45-degree field of view:
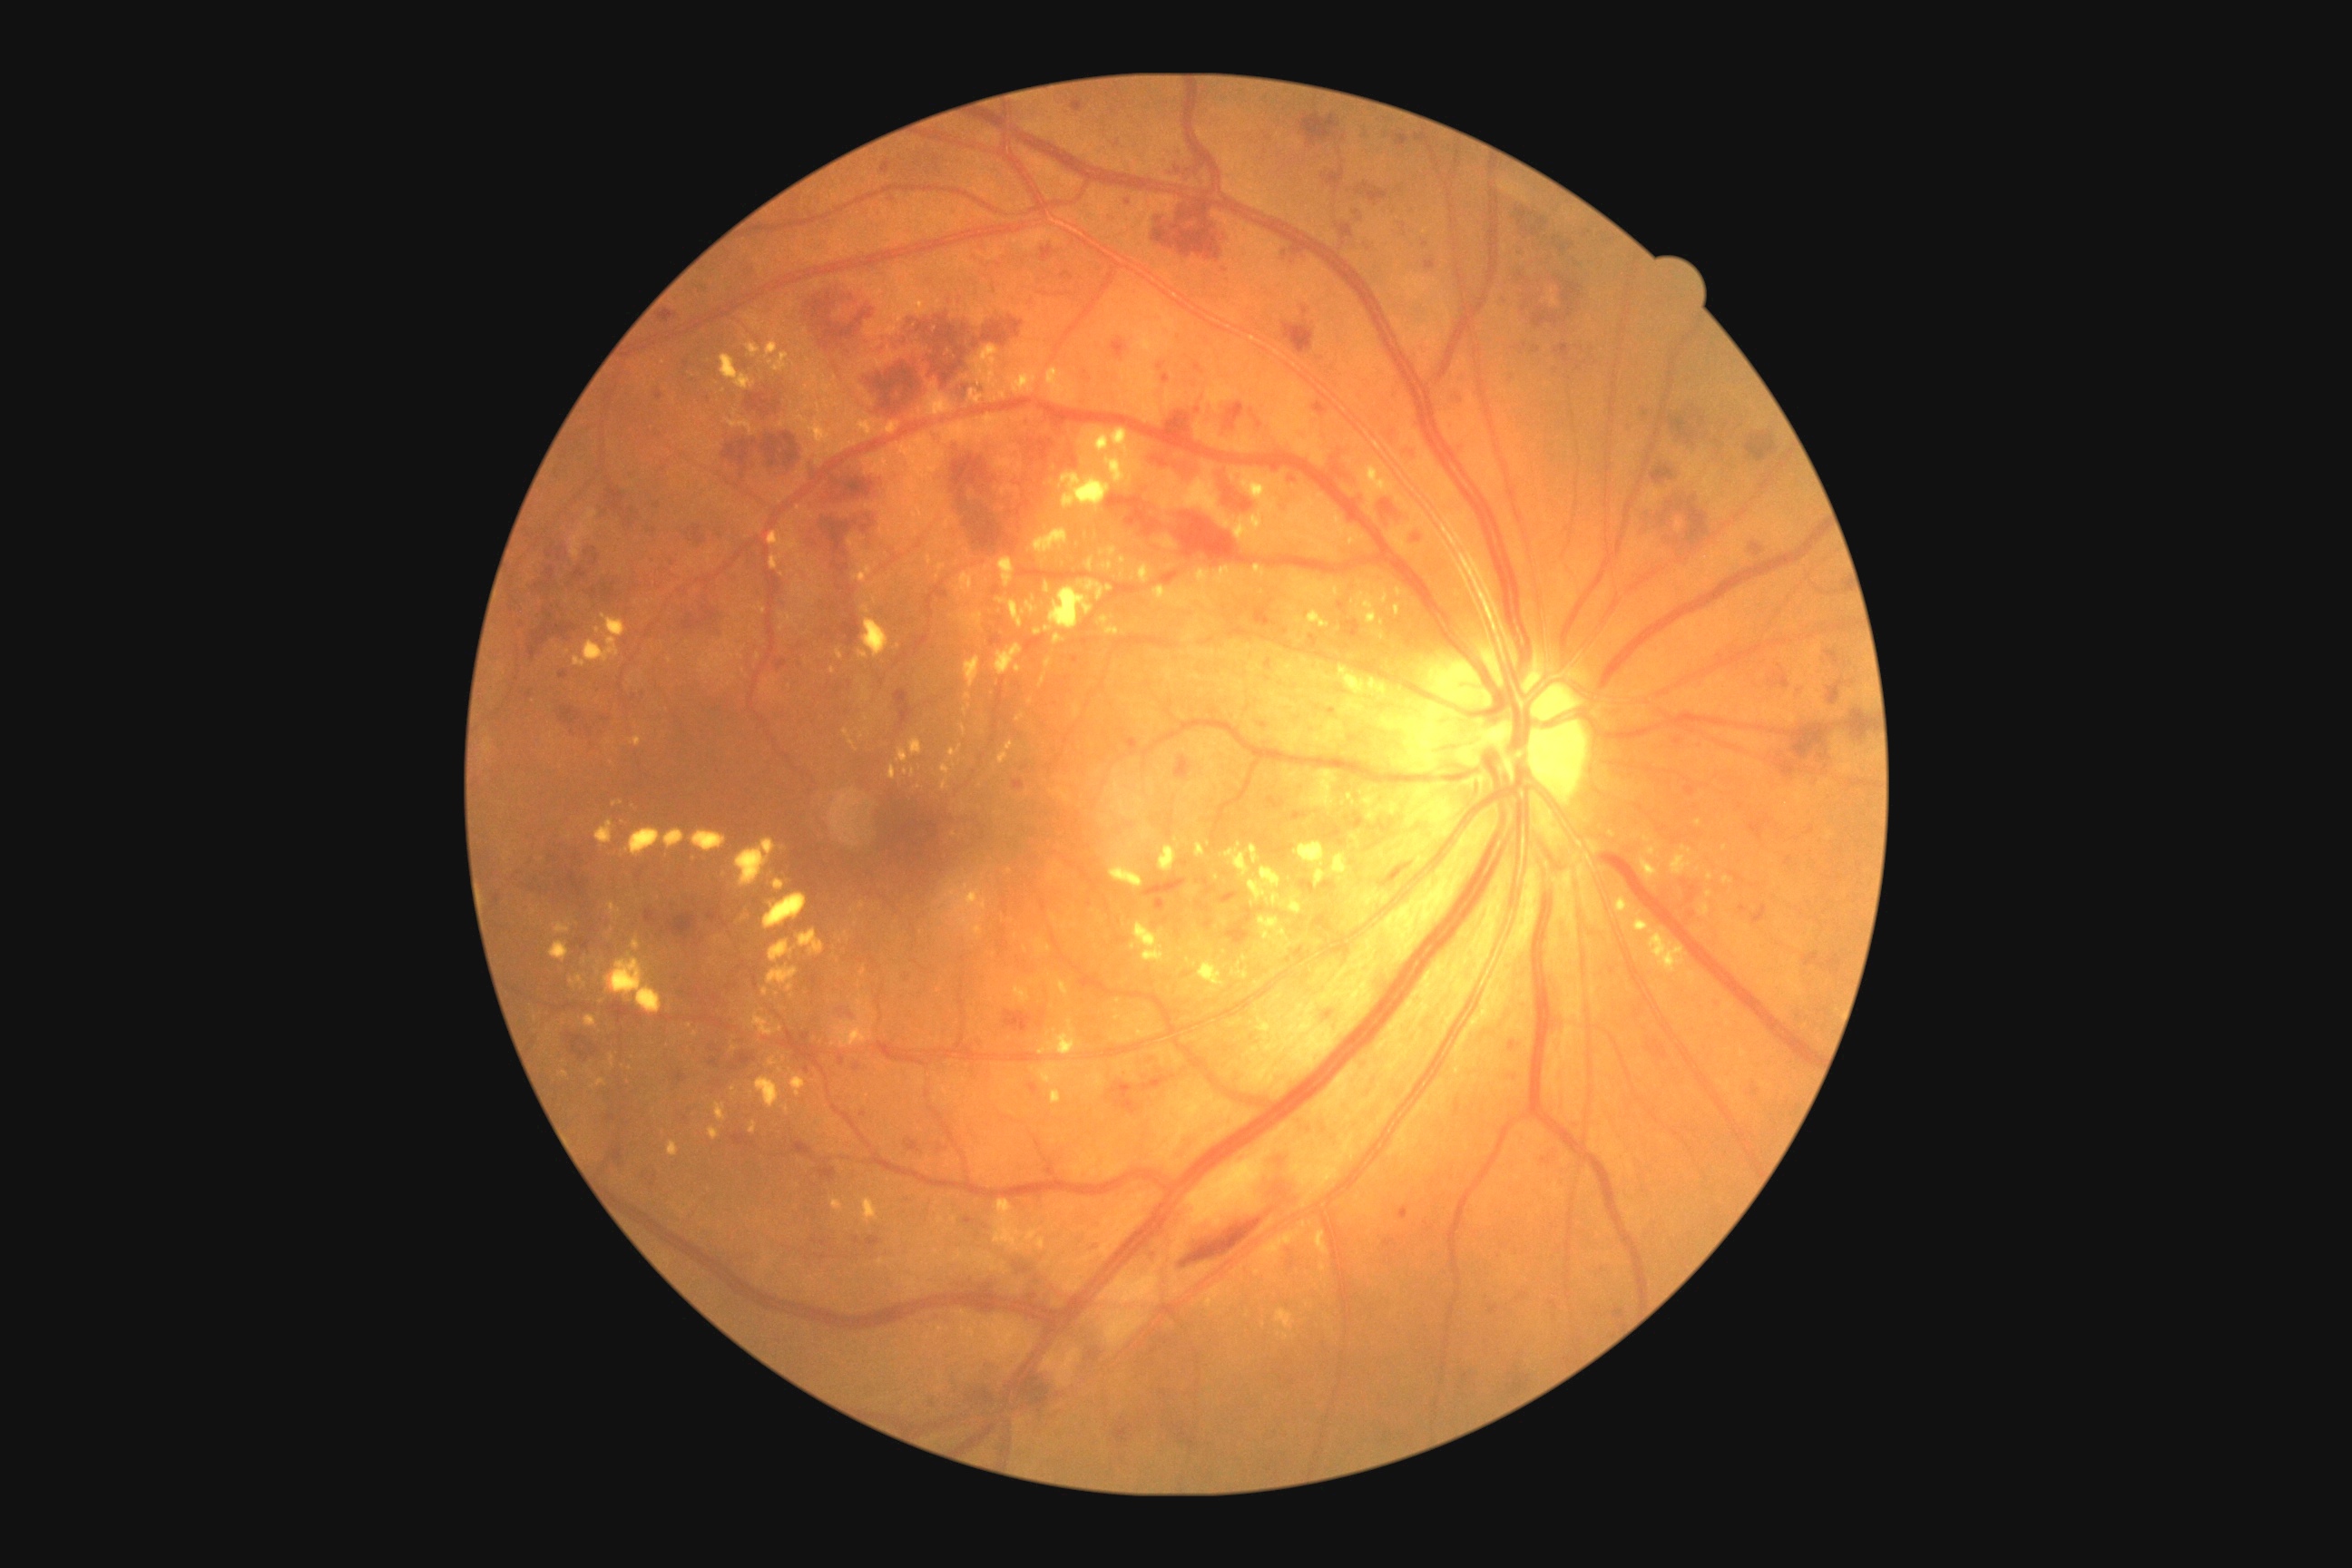 partial: true
dr_grade: 3
lesions:
  ma:
    - {"x1": 990, "y1": 634, "x2": 1003, "y2": 647}
    - {"x1": 1426, "y1": 260, "x2": 1436, "y2": 270}
    - {"x1": 1807, "y1": 827, "x2": 1816, "y2": 836}
    - {"x1": 654, "y1": 391, "x2": 663, "y2": 400}
    - {"x1": 805, "y1": 1066, "x2": 810, "y2": 1075}
    - {"x1": 1313, "y1": 402, "x2": 1329, "y2": 416}
    - {"x1": 1398, "y1": 1208, "x2": 1409, "y2": 1220}
    - {"x1": 605, "y1": 1115, "x2": 618, "y2": 1124}
    - {"x1": 937, "y1": 1142, "x2": 948, "y2": 1153}
    - {"x1": 1219, "y1": 892, "x2": 1240, "y2": 905}
    - {"x1": 1752, "y1": 1086, "x2": 1759, "y2": 1095}
    - {"x1": 1210, "y1": 709, "x2": 1219, "y2": 716}
    - {"x1": 881, "y1": 161, "x2": 892, "y2": 173}
    - {"x1": 1019, "y1": 1268, "x2": 1032, "y2": 1273}
    - {"x1": 1164, "y1": 917, "x2": 1170, "y2": 925}
    - {"x1": 1197, "y1": 879, "x2": 1217, "y2": 896}
    - {"x1": 605, "y1": 1144, "x2": 625, "y2": 1164}
  ma_small_centers:
    - {"x": 1185, "y": 864}
    - {"x": 657, "y": 506}
  he:
    - {"x1": 1181, "y1": 1208, "x2": 1277, "y2": 1268}
    - {"x1": 1337, "y1": 224, "x2": 1355, "y2": 251}
    - {"x1": 1175, "y1": 758, "x2": 1191, "y2": 779}
    - {"x1": 558, "y1": 671, "x2": 569, "y2": 680}
    - {"x1": 618, "y1": 1148, "x2": 625, "y2": 1164}
    - {"x1": 602, "y1": 583, "x2": 618, "y2": 602}
    - {"x1": 591, "y1": 589, "x2": 598, "y2": 600}
    - {"x1": 687, "y1": 525, "x2": 707, "y2": 545}
    - {"x1": 527, "y1": 609, "x2": 578, "y2": 663}
    - {"x1": 816, "y1": 1159, "x2": 838, "y2": 1184}
    - {"x1": 1393, "y1": 133, "x2": 1409, "y2": 148}
    - {"x1": 1106, "y1": 495, "x2": 1162, "y2": 538}
    - {"x1": 536, "y1": 538, "x2": 542, "y2": 547}
    - {"x1": 1280, "y1": 308, "x2": 1315, "y2": 355}
    - {"x1": 836, "y1": 607, "x2": 861, "y2": 647}
    - {"x1": 636, "y1": 567, "x2": 672, "y2": 587}
    - {"x1": 1106, "y1": 1081, "x2": 1141, "y2": 1115}
    - {"x1": 1355, "y1": 182, "x2": 1389, "y2": 208}
  he_small_centers:
    - {"x": 912, "y": 322}
    - {"x": 852, "y": 297}
  ex:
    - {"x1": 1059, "y1": 473, "x2": 1112, "y2": 513}
    - {"x1": 850, "y1": 545, "x2": 861, "y2": 551}
    - {"x1": 1317, "y1": 774, "x2": 1333, "y2": 794}
    - {"x1": 926, "y1": 554, "x2": 932, "y2": 564}
    - {"x1": 1048, "y1": 1019, "x2": 1083, "y2": 1055}
    - {"x1": 1050, "y1": 1090, "x2": 1063, "y2": 1104}
    - {"x1": 836, "y1": 649, "x2": 843, "y2": 660}
    - {"x1": 725, "y1": 418, "x2": 761, "y2": 436}
    - {"x1": 995, "y1": 645, "x2": 1023, "y2": 676}
    - {"x1": 970, "y1": 389, "x2": 985, "y2": 406}
    - {"x1": 1102, "y1": 562, "x2": 1113, "y2": 571}
    - {"x1": 1104, "y1": 627, "x2": 1121, "y2": 636}
    - {"x1": 1311, "y1": 1231, "x2": 1329, "y2": 1255}
    - {"x1": 1015, "y1": 712, "x2": 1026, "y2": 723}
    - {"x1": 912, "y1": 769, "x2": 916, "y2": 778}
    - {"x1": 605, "y1": 952, "x2": 663, "y2": 1014}
  ex_small_centers:
    - {"x": 834, "y": 1044}
    - {"x": 1031, "y": 702}
    - {"x": 1122, "y": 575}